Acquired with a NIDEK AFC-230
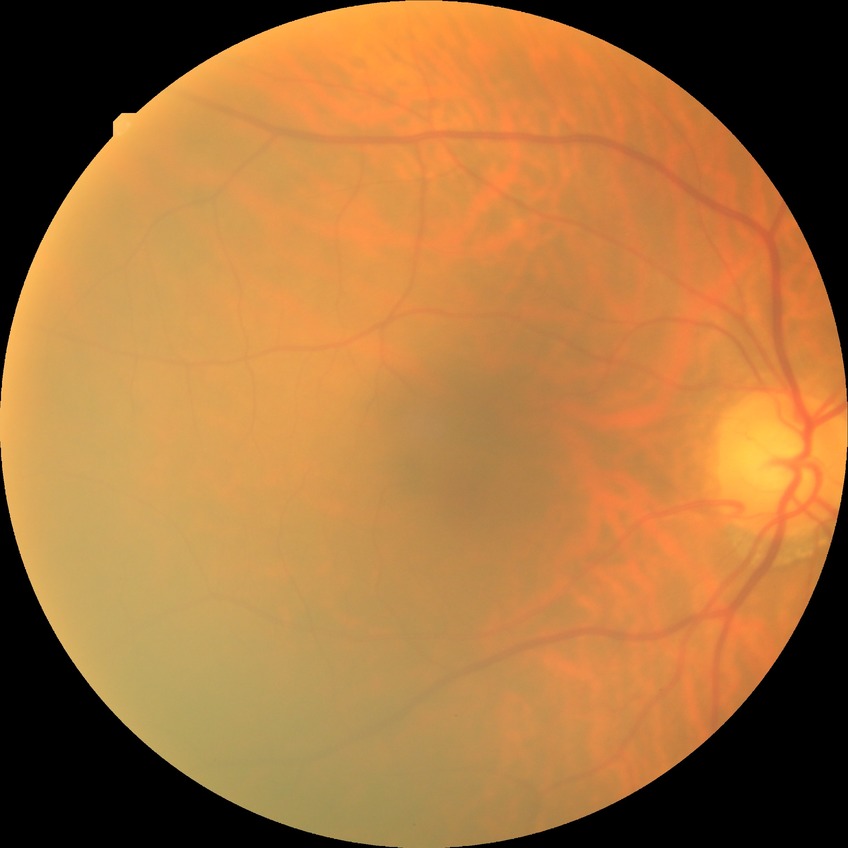

diabetic retinopathy stage = no diabetic retinopathy.